FOV: 45 degrees:
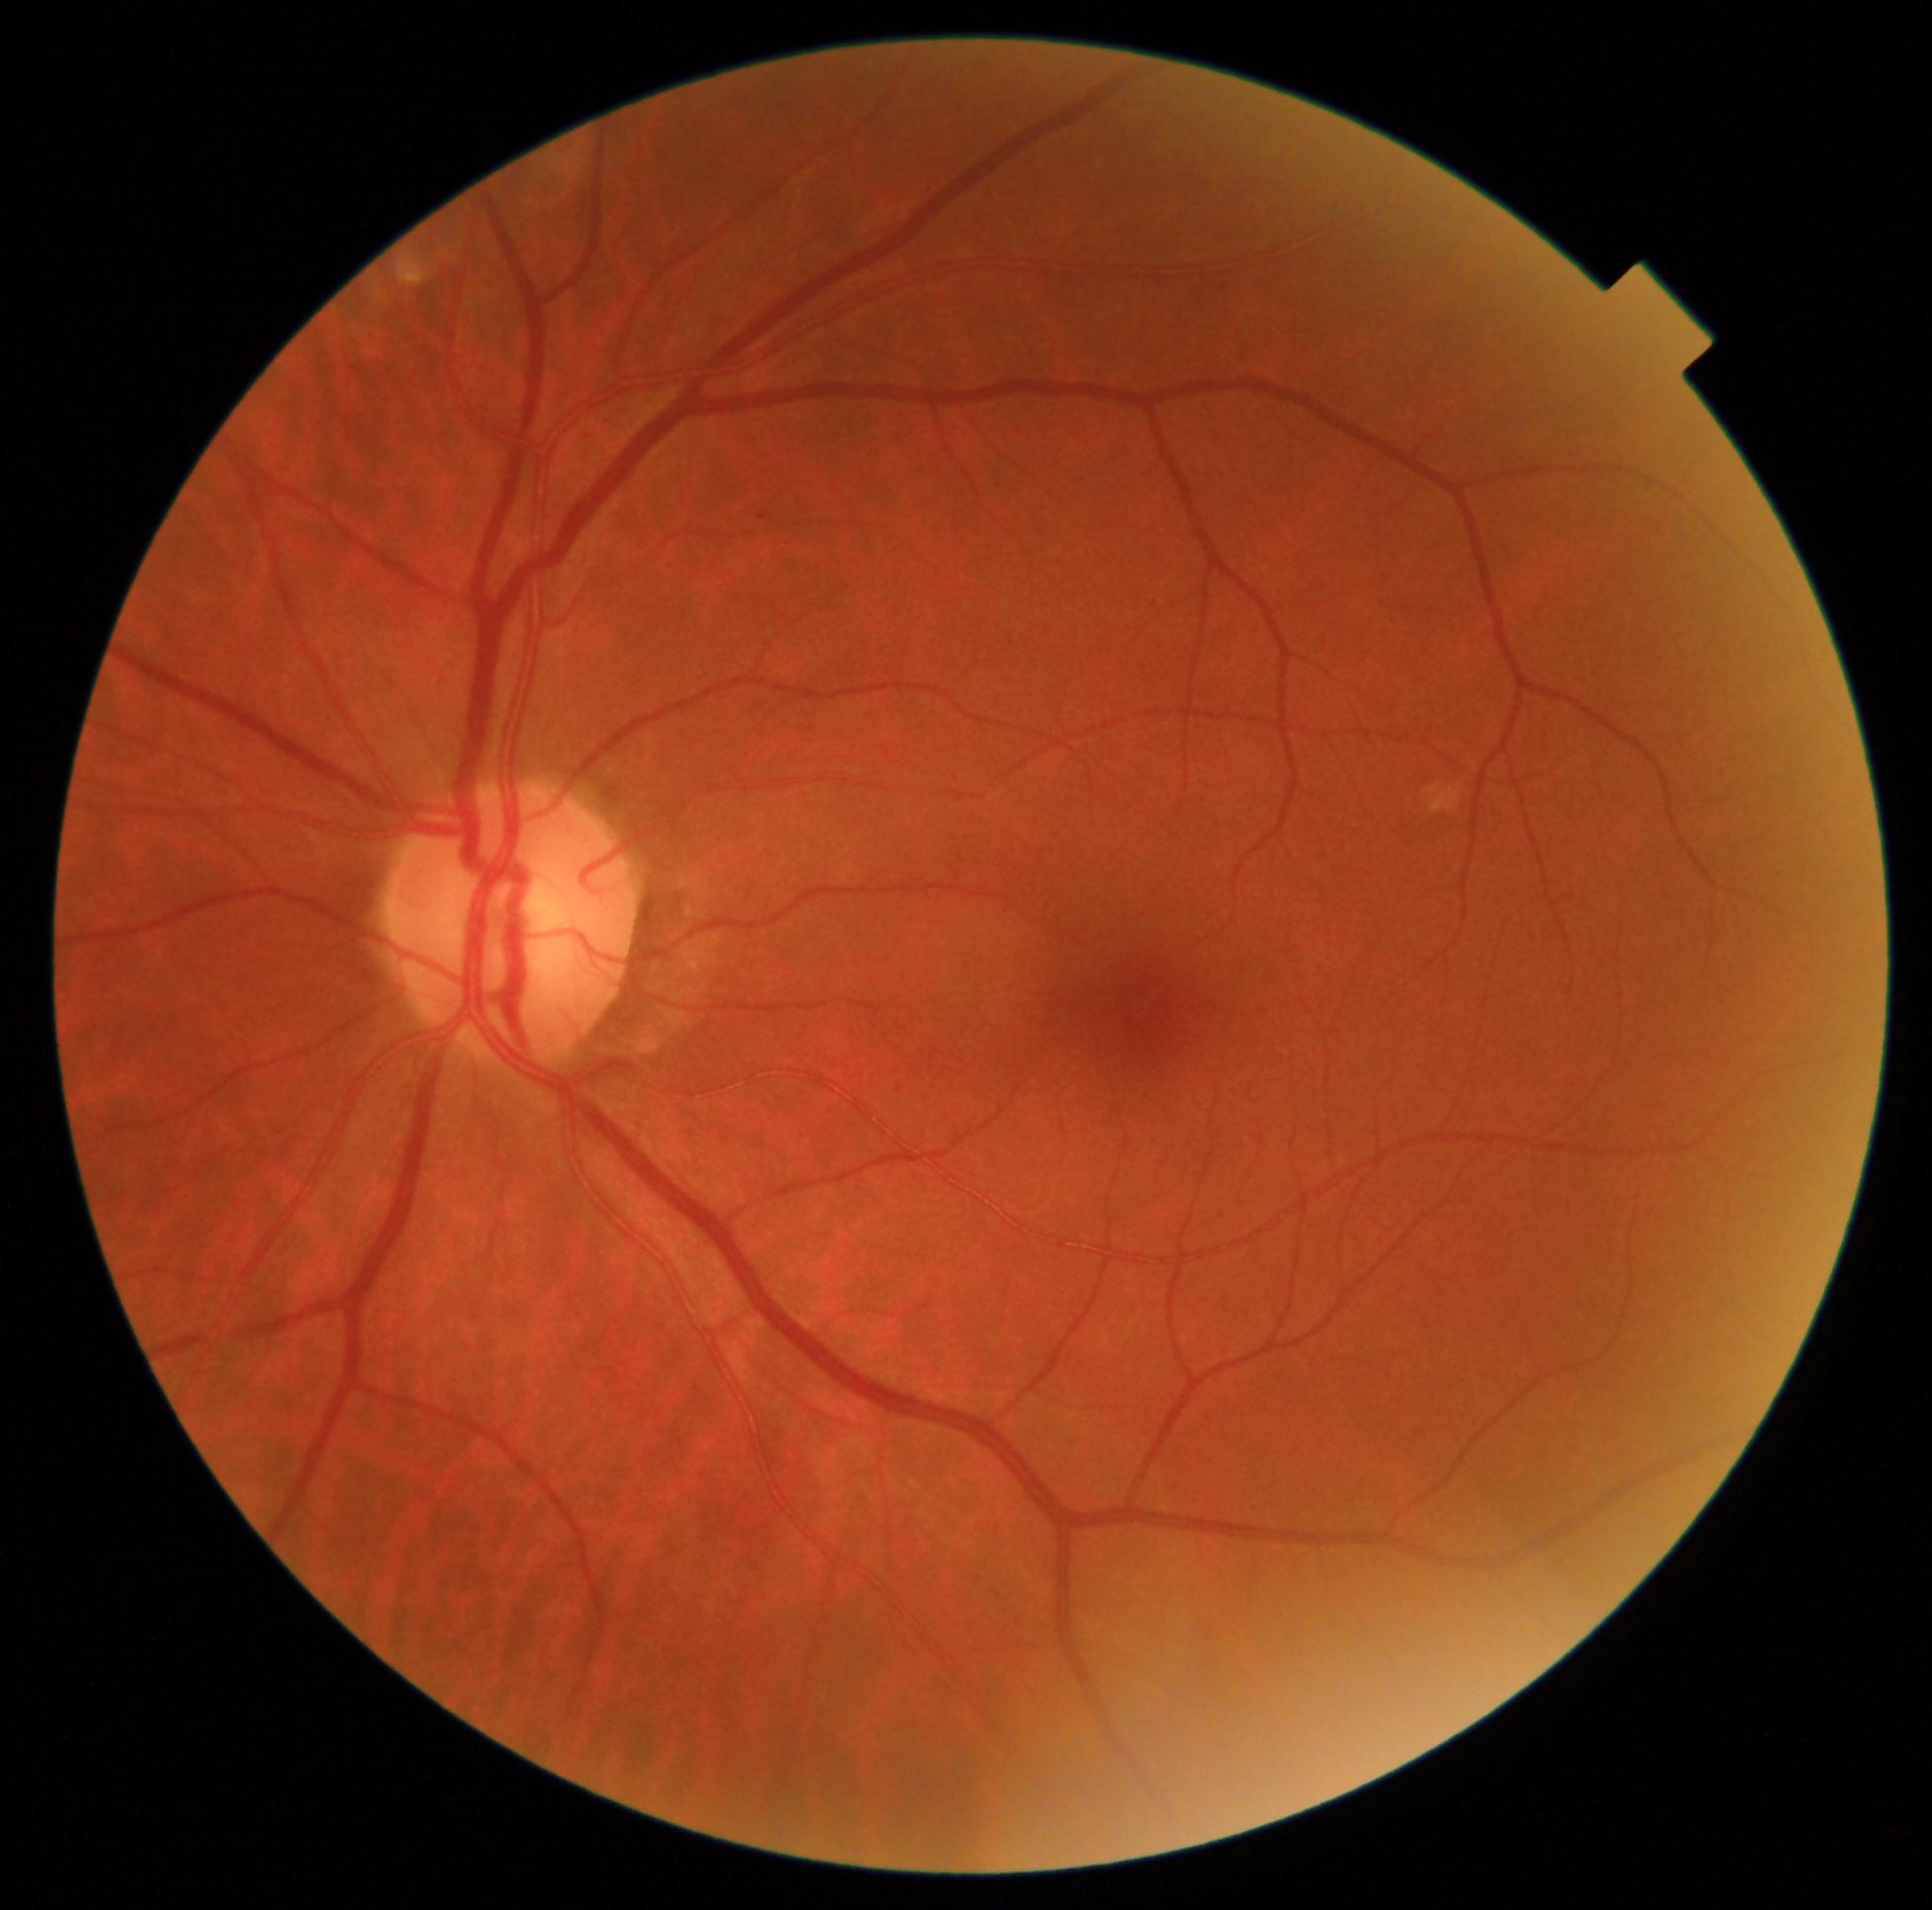 DR stage: no apparent diabetic retinopathy (grade 0) — no visible signs of diabetic retinopathy.